Davis DR grading, 45° field of view: 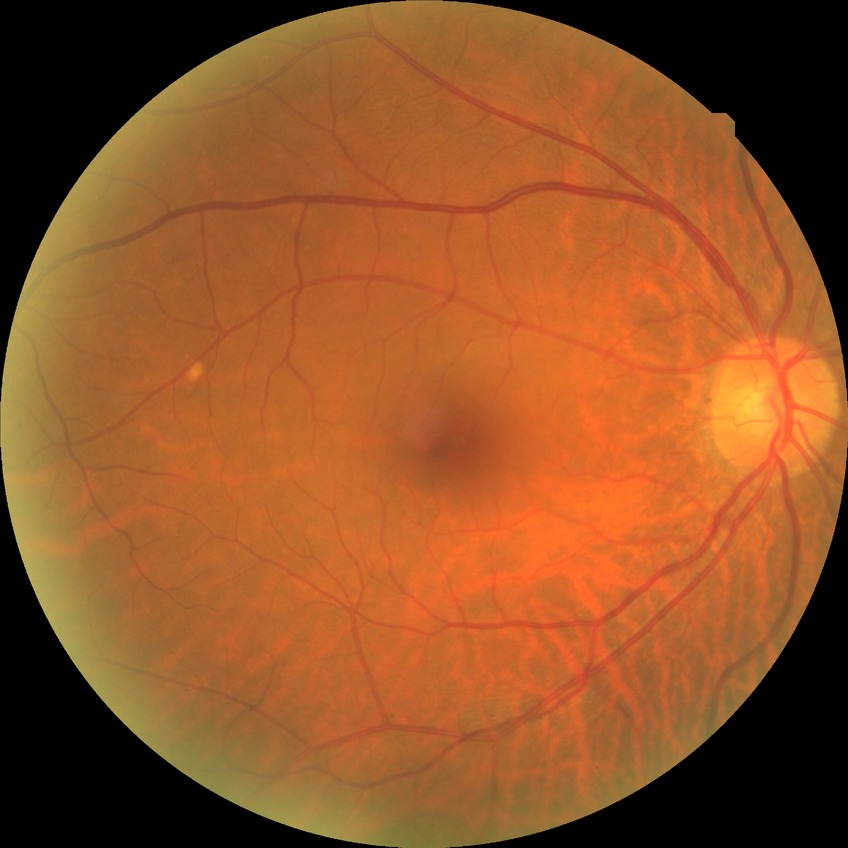 Diabetic retinopathy stage is no diabetic retinopathy.